45-degree field of view: 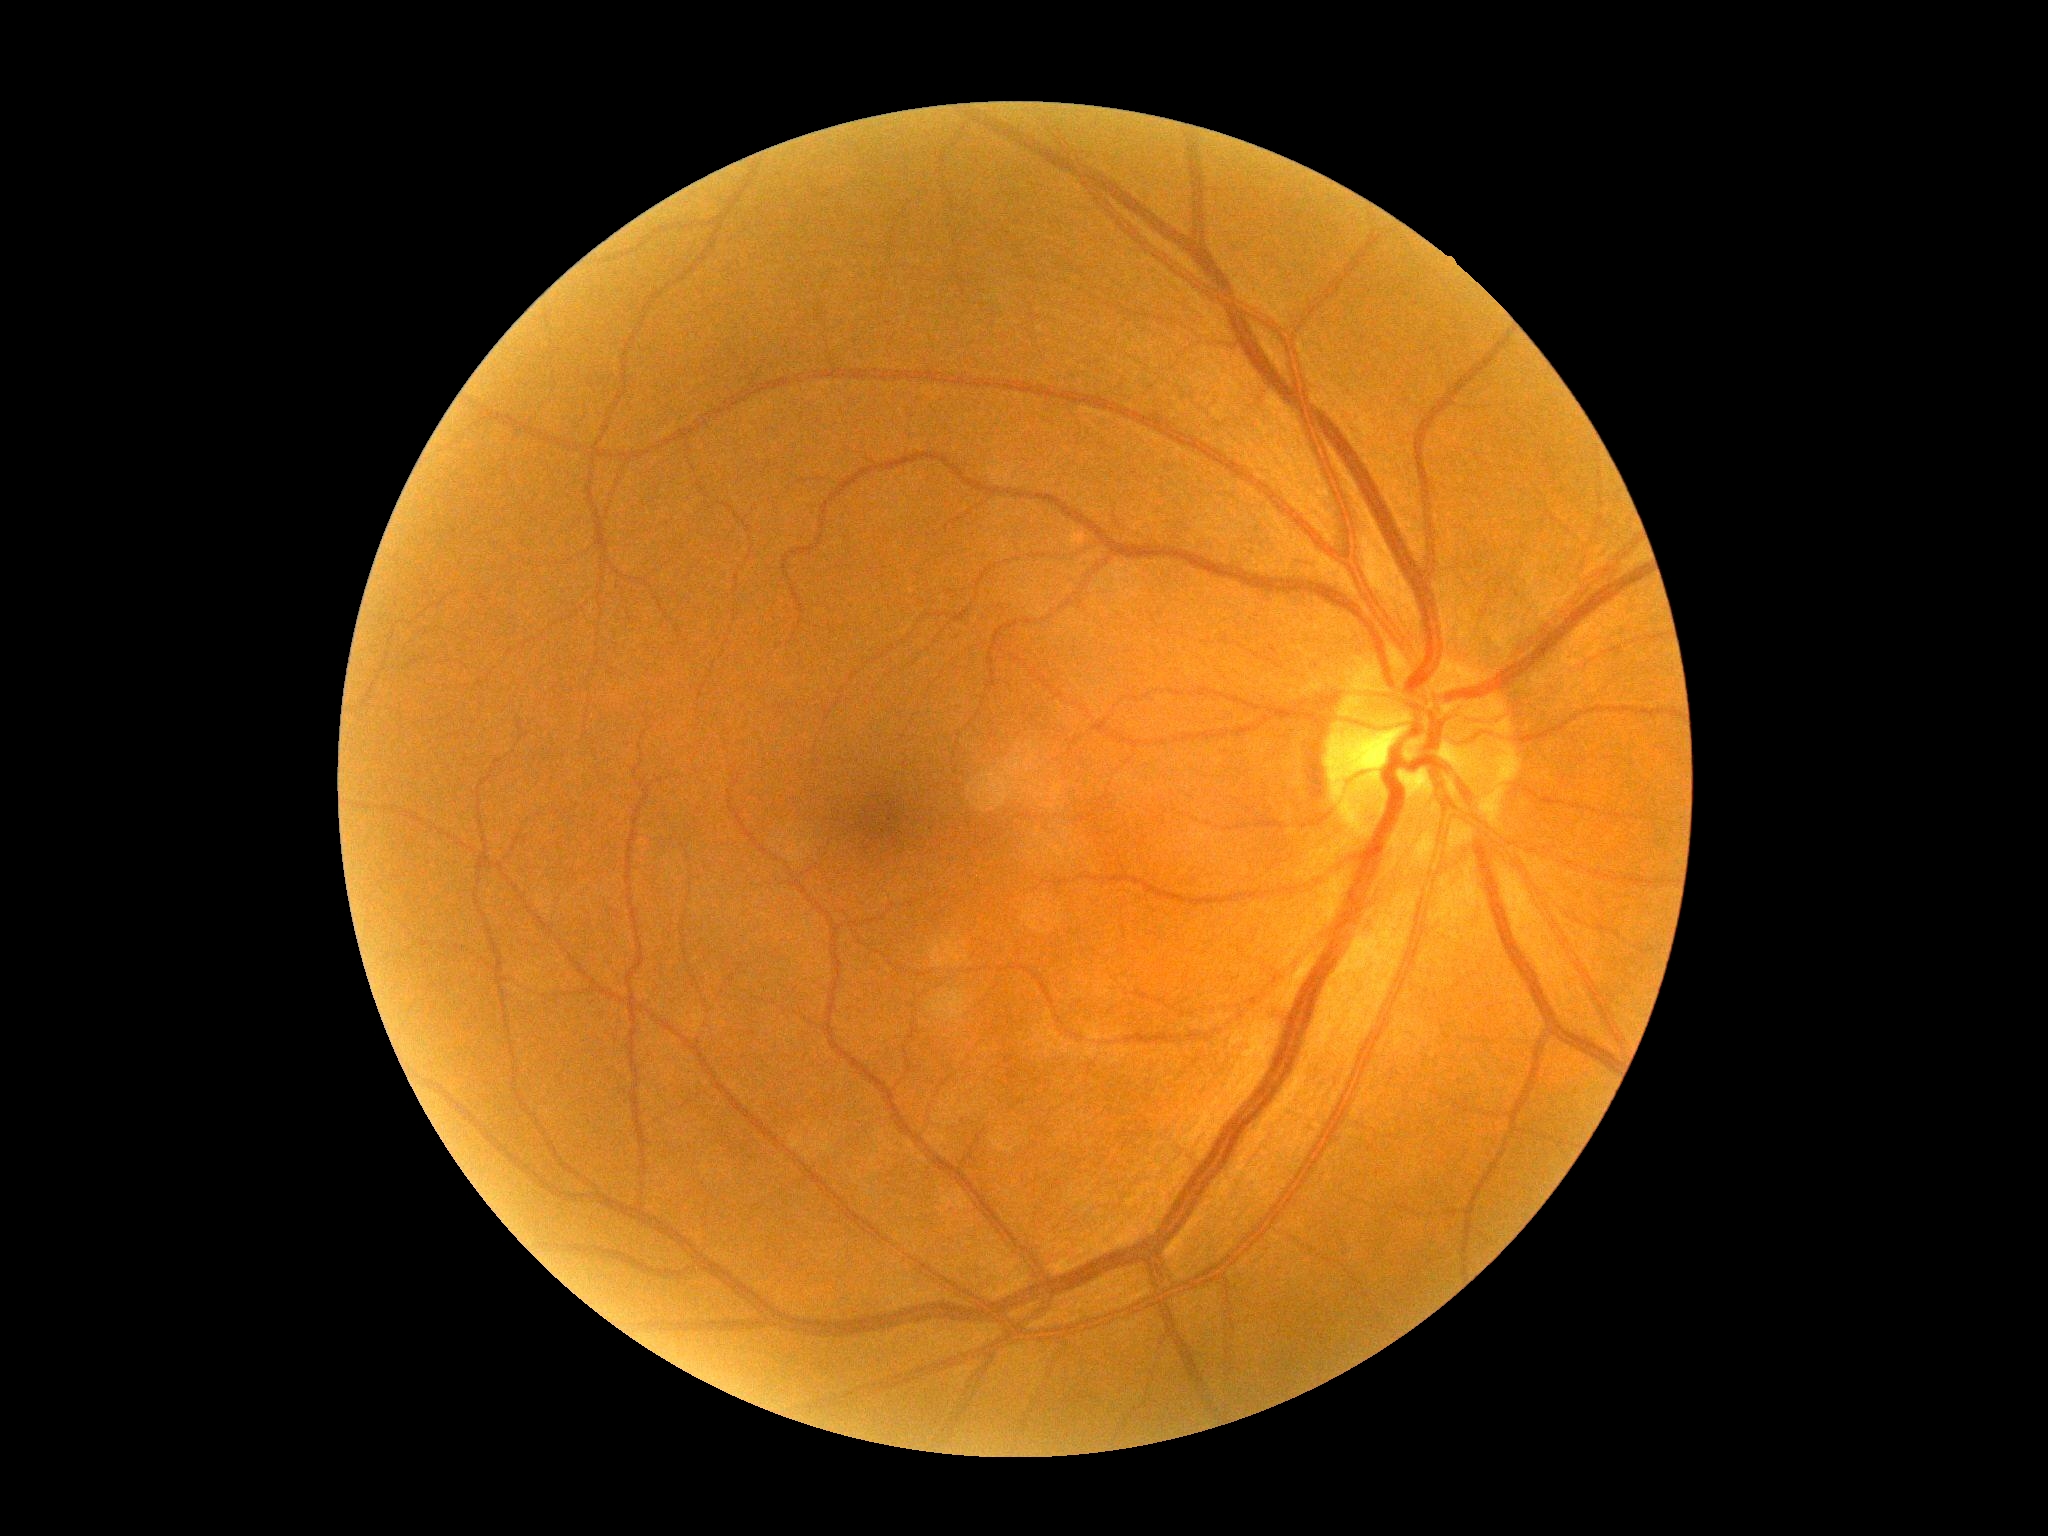
DR impression=negative for DR; DR grade=0.